Color fundus photograph, 1932 by 1910 pixels
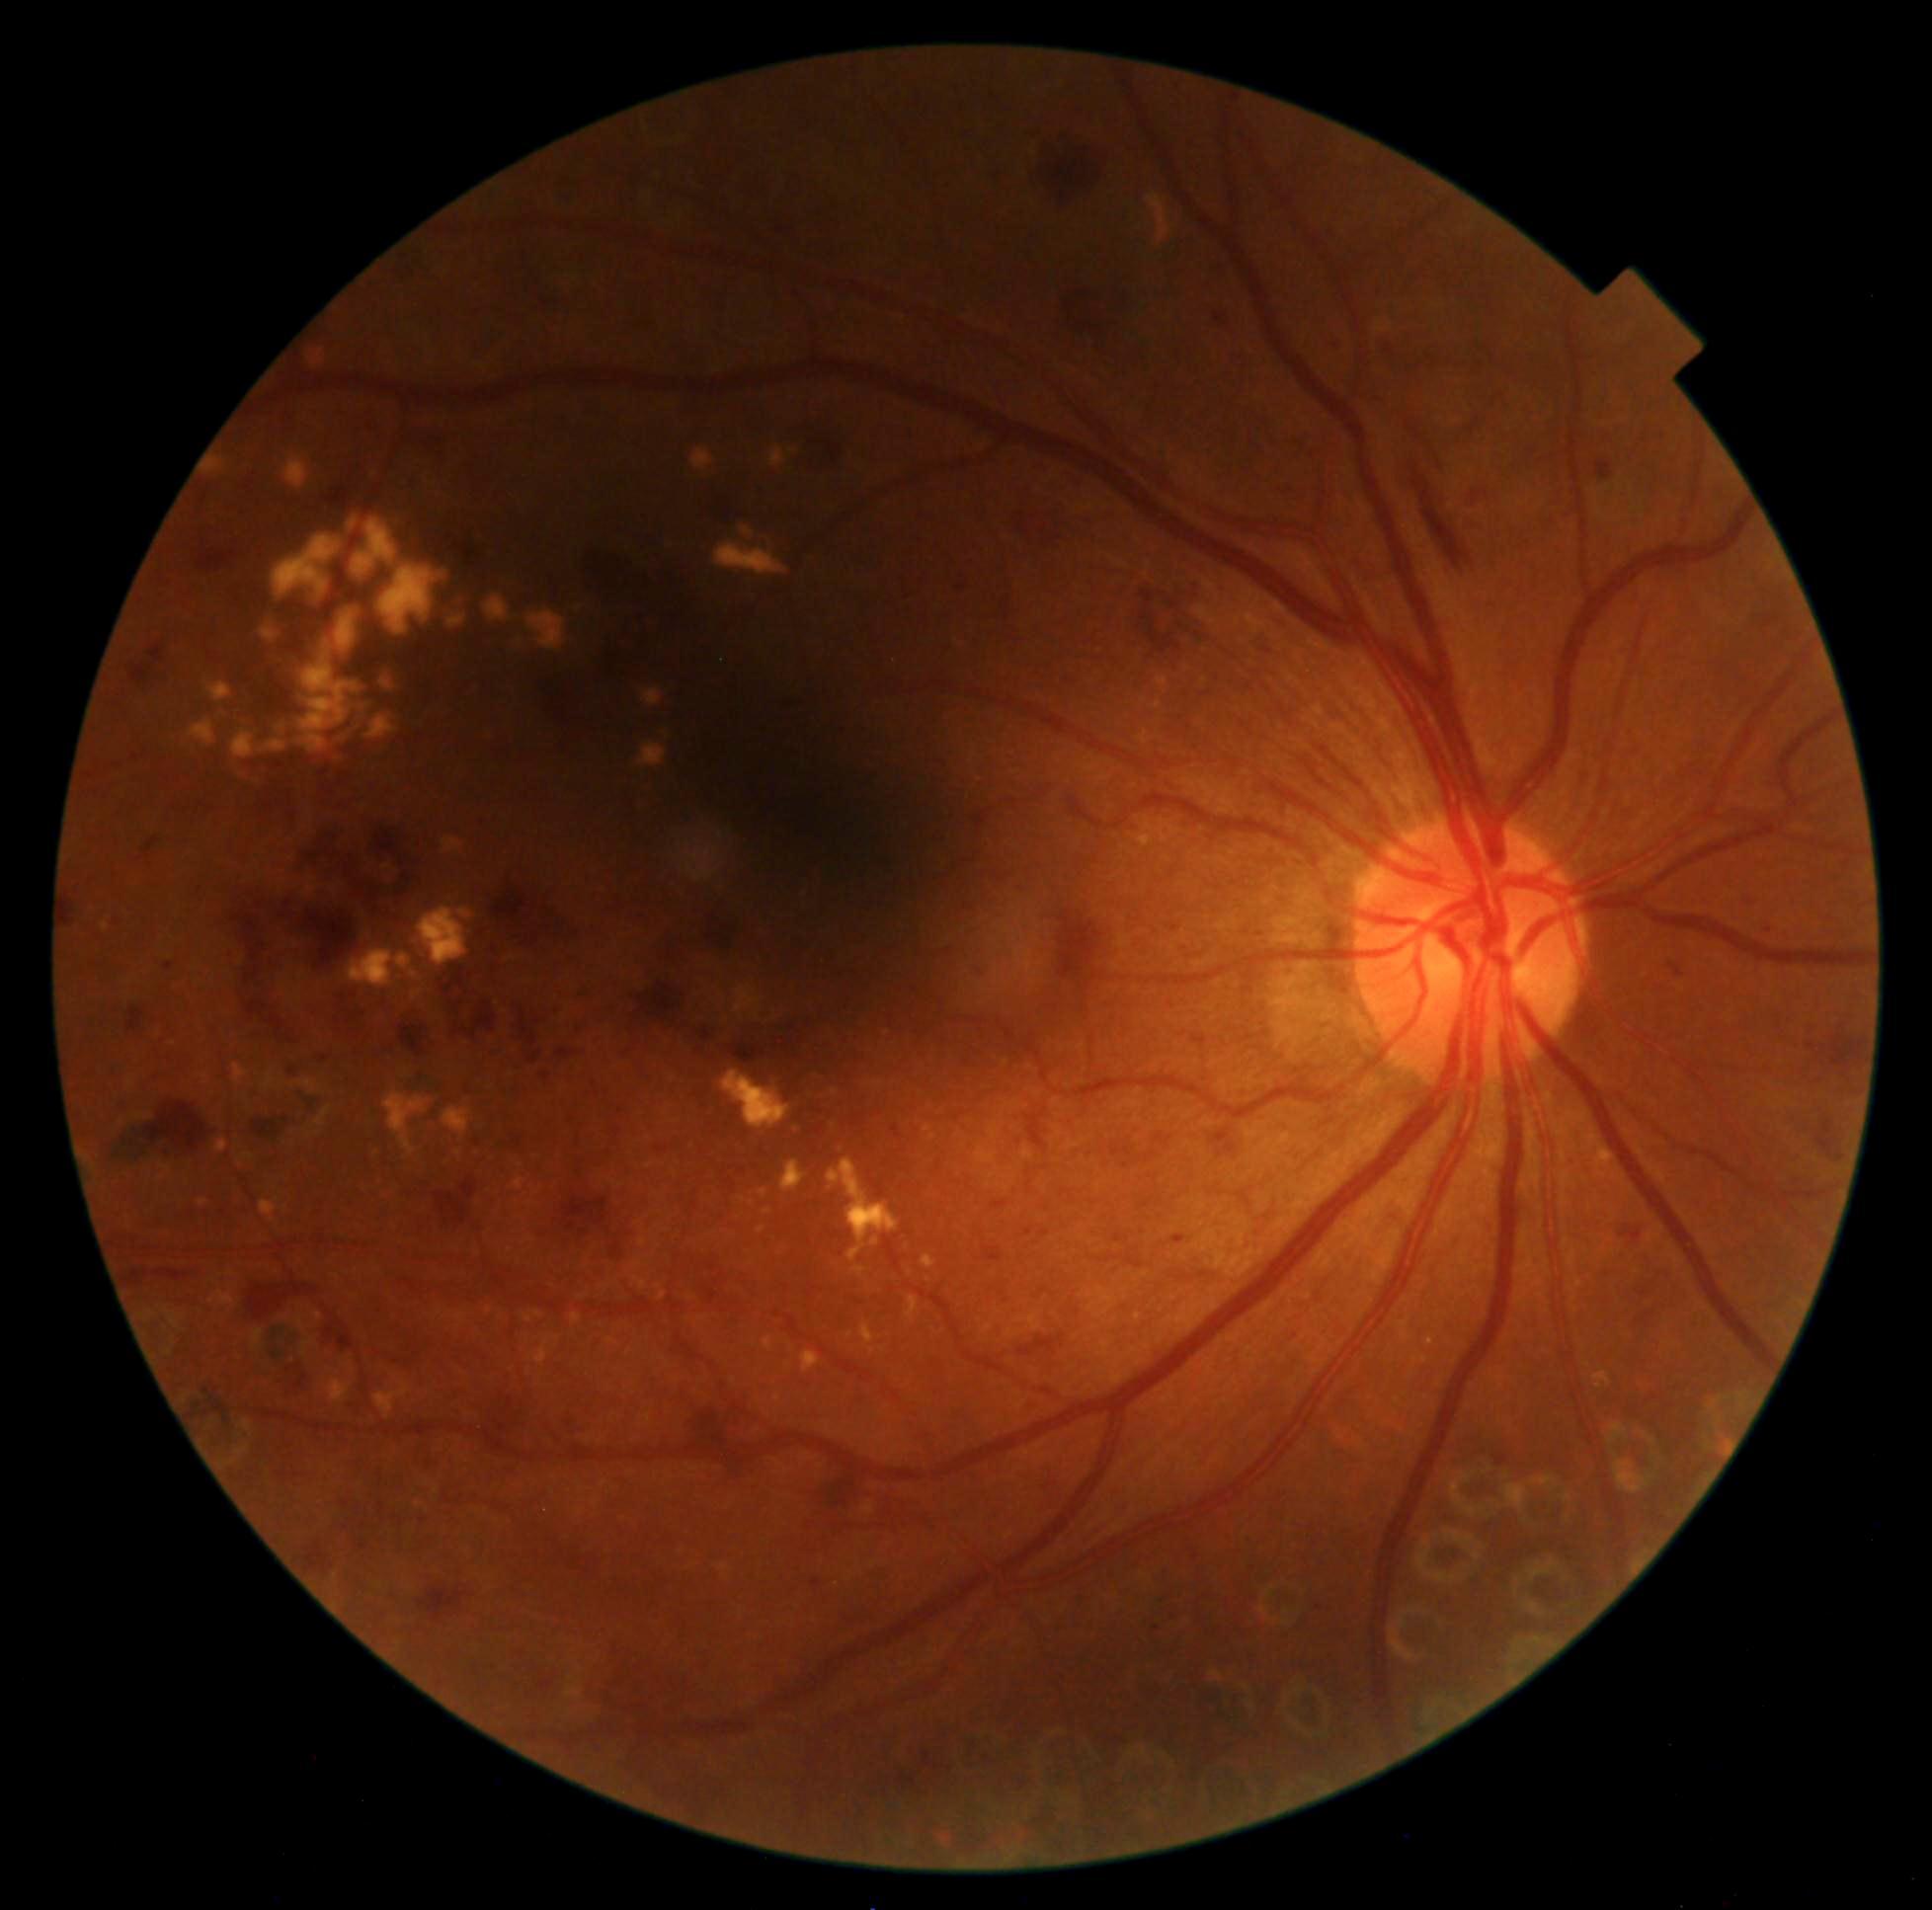 Diabetic retinopathy: grade 3.